Infant wide-field retinal image:
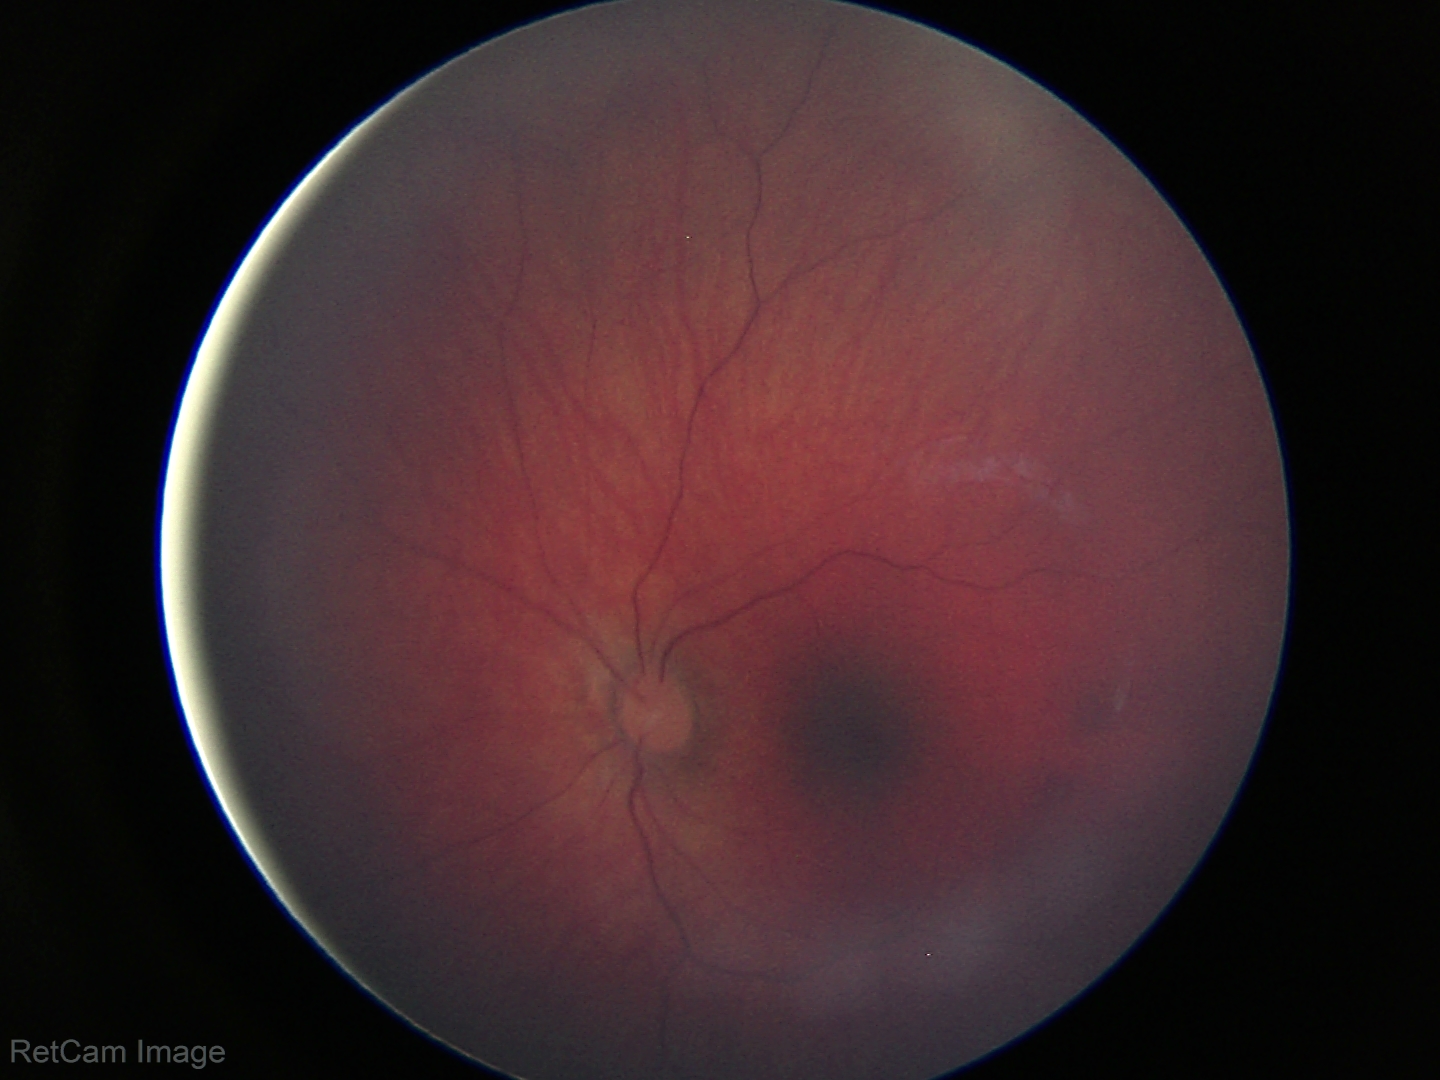
Normal screening examination.